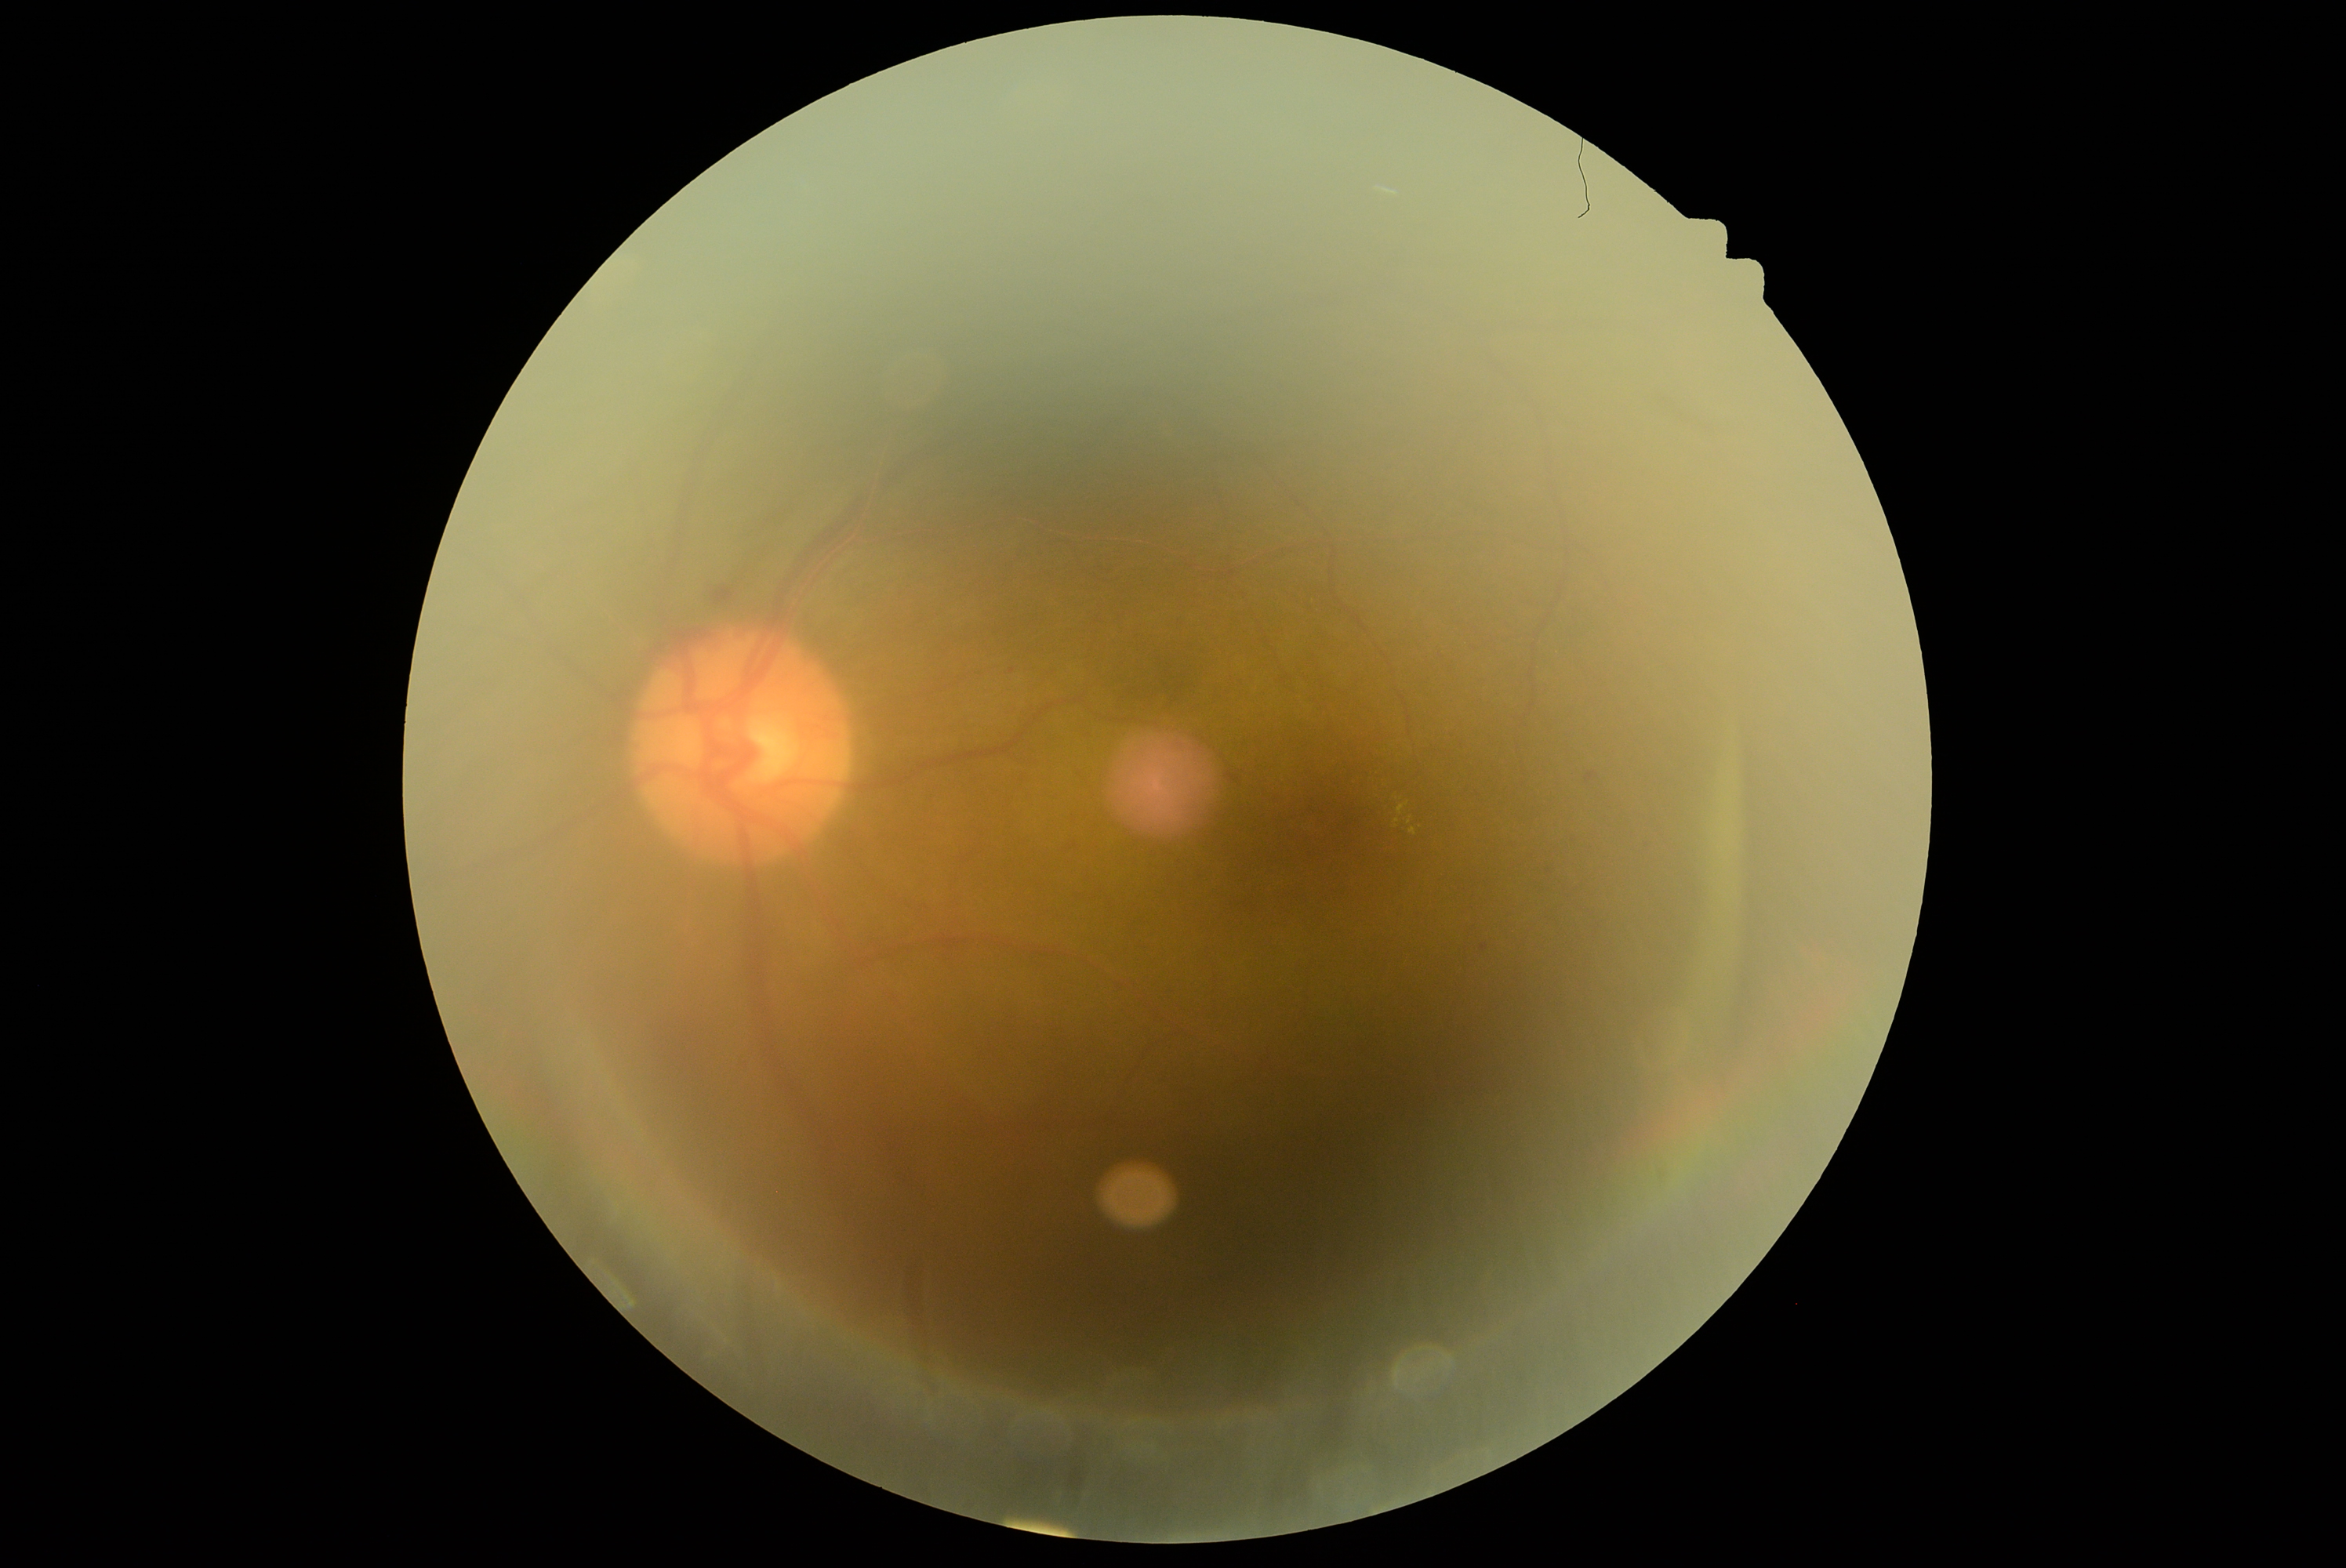
Retinopathy grade is 2.